1932 by 1932 pixels:
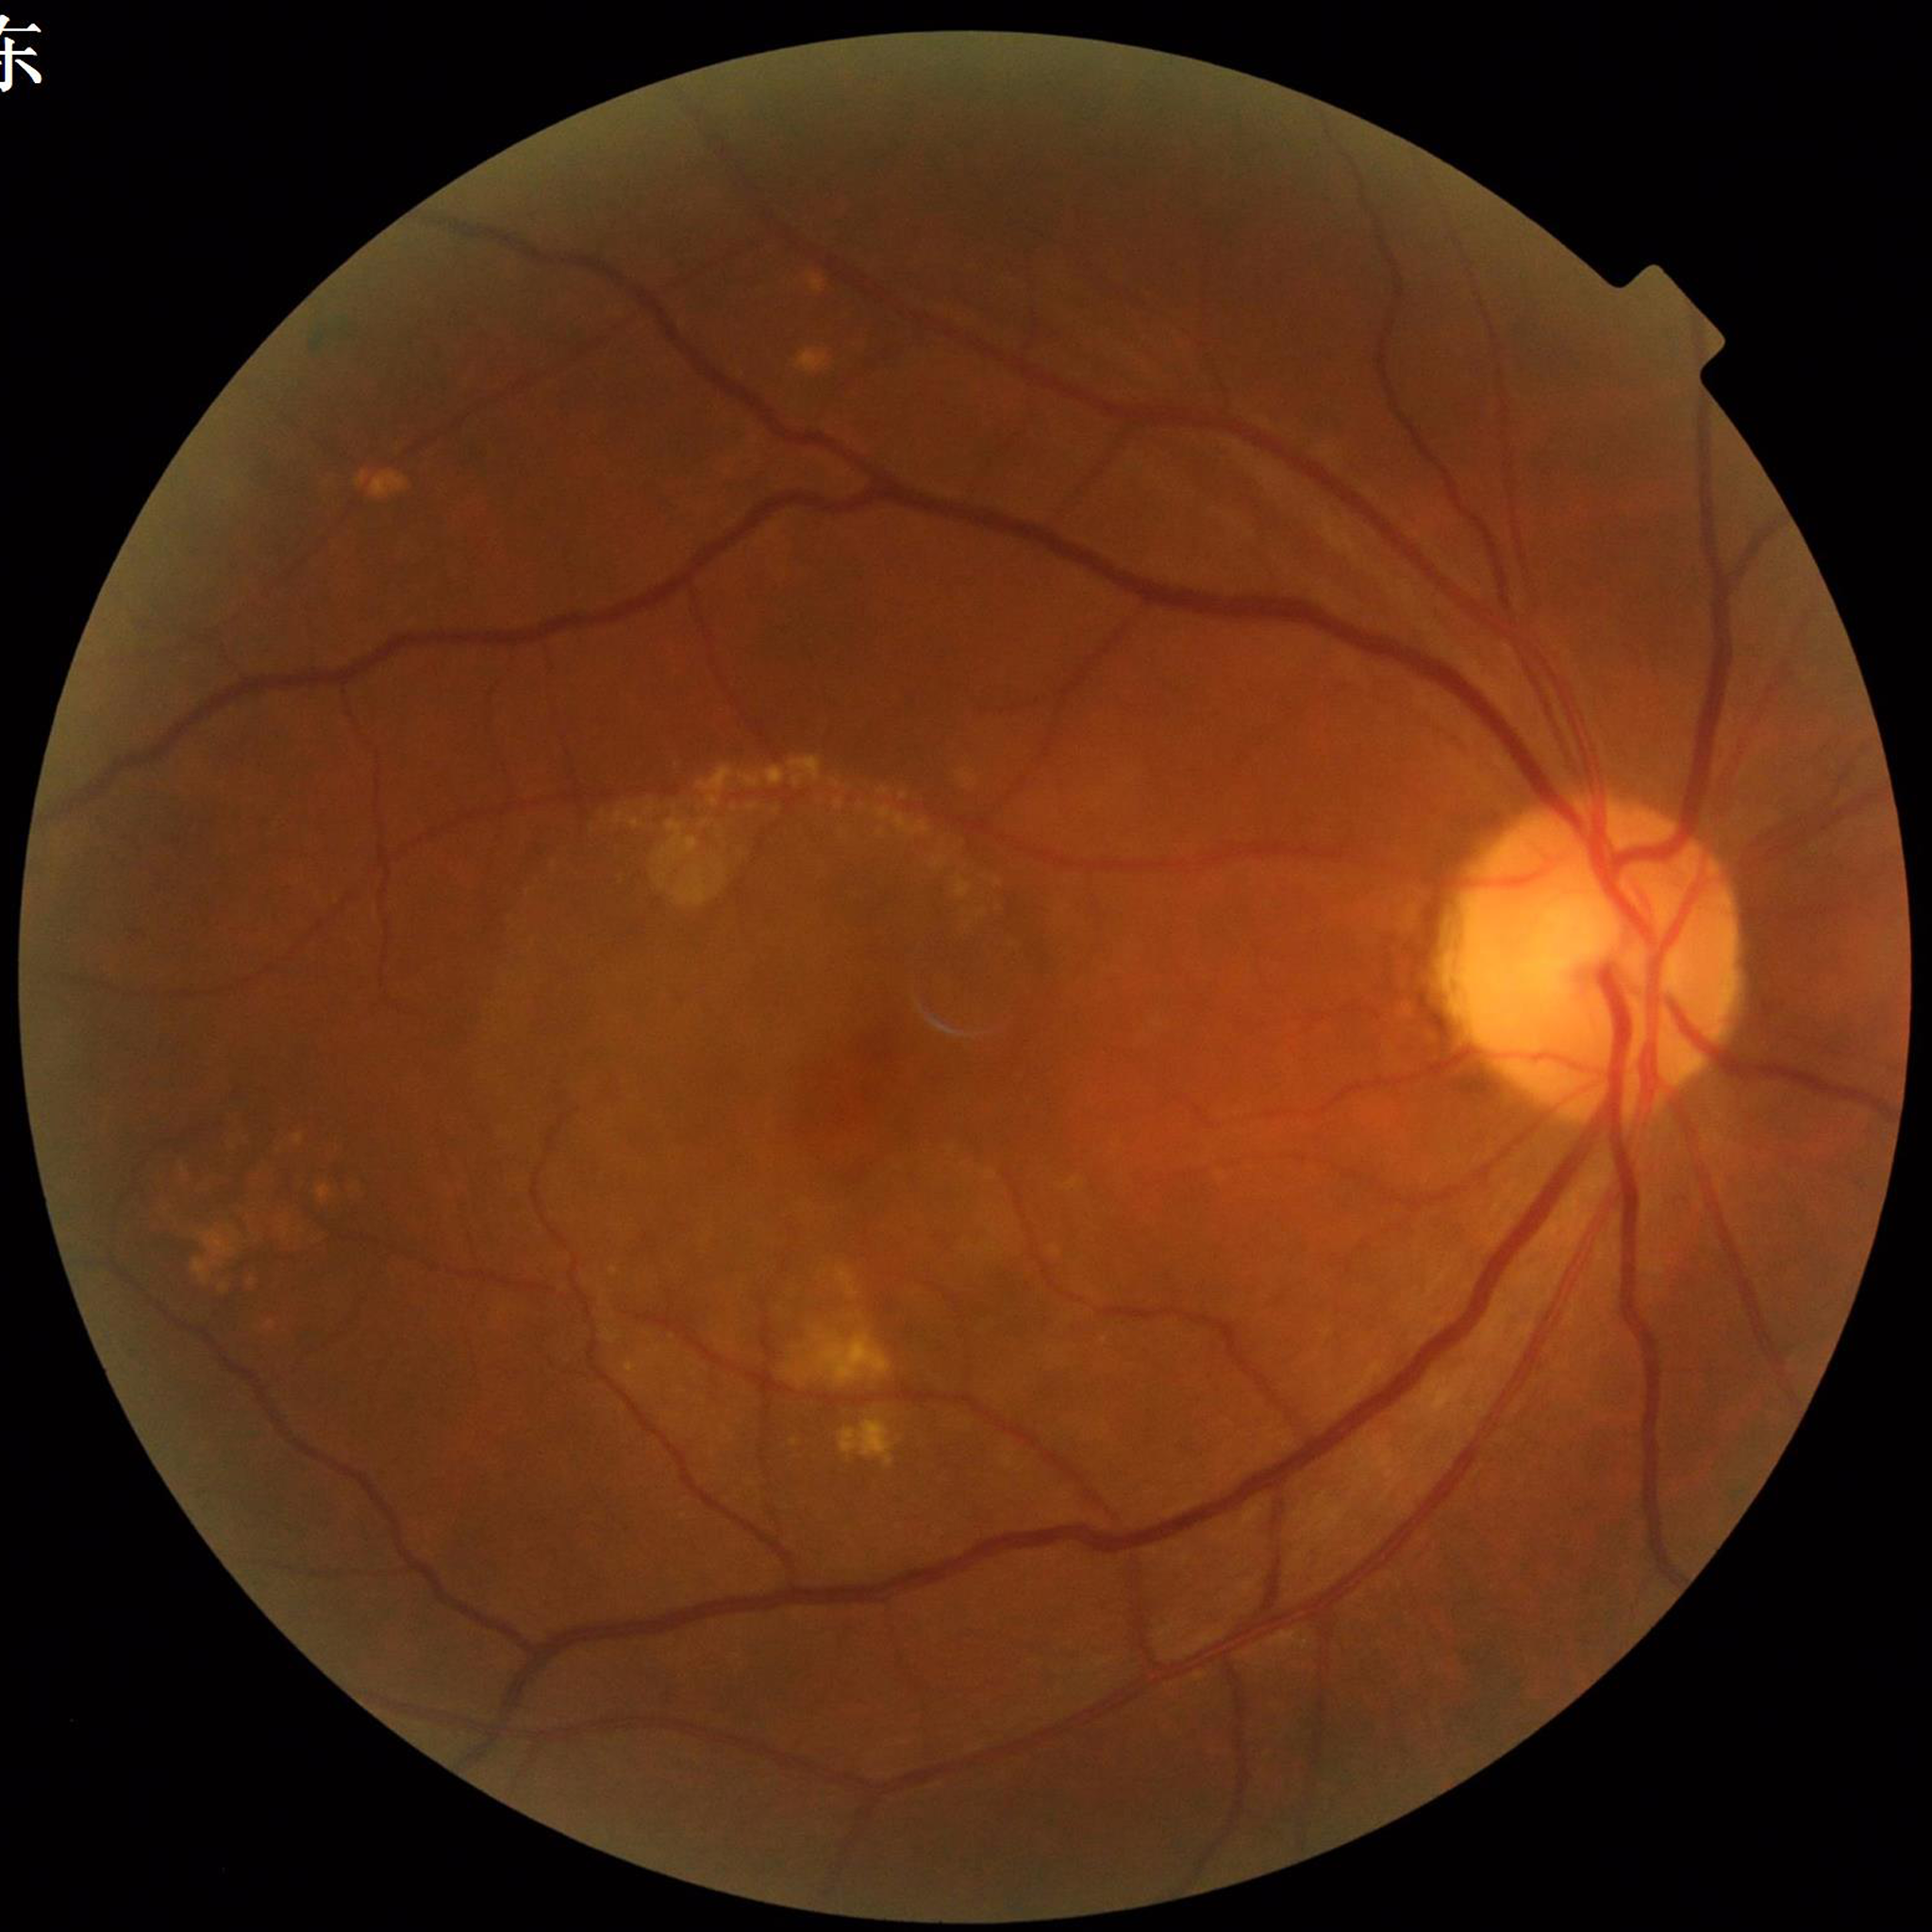
Impression: age-related macular degeneration; Photo quality: no concerns identified.